Retinal fundus photograph. 2352 by 1568 pixels: 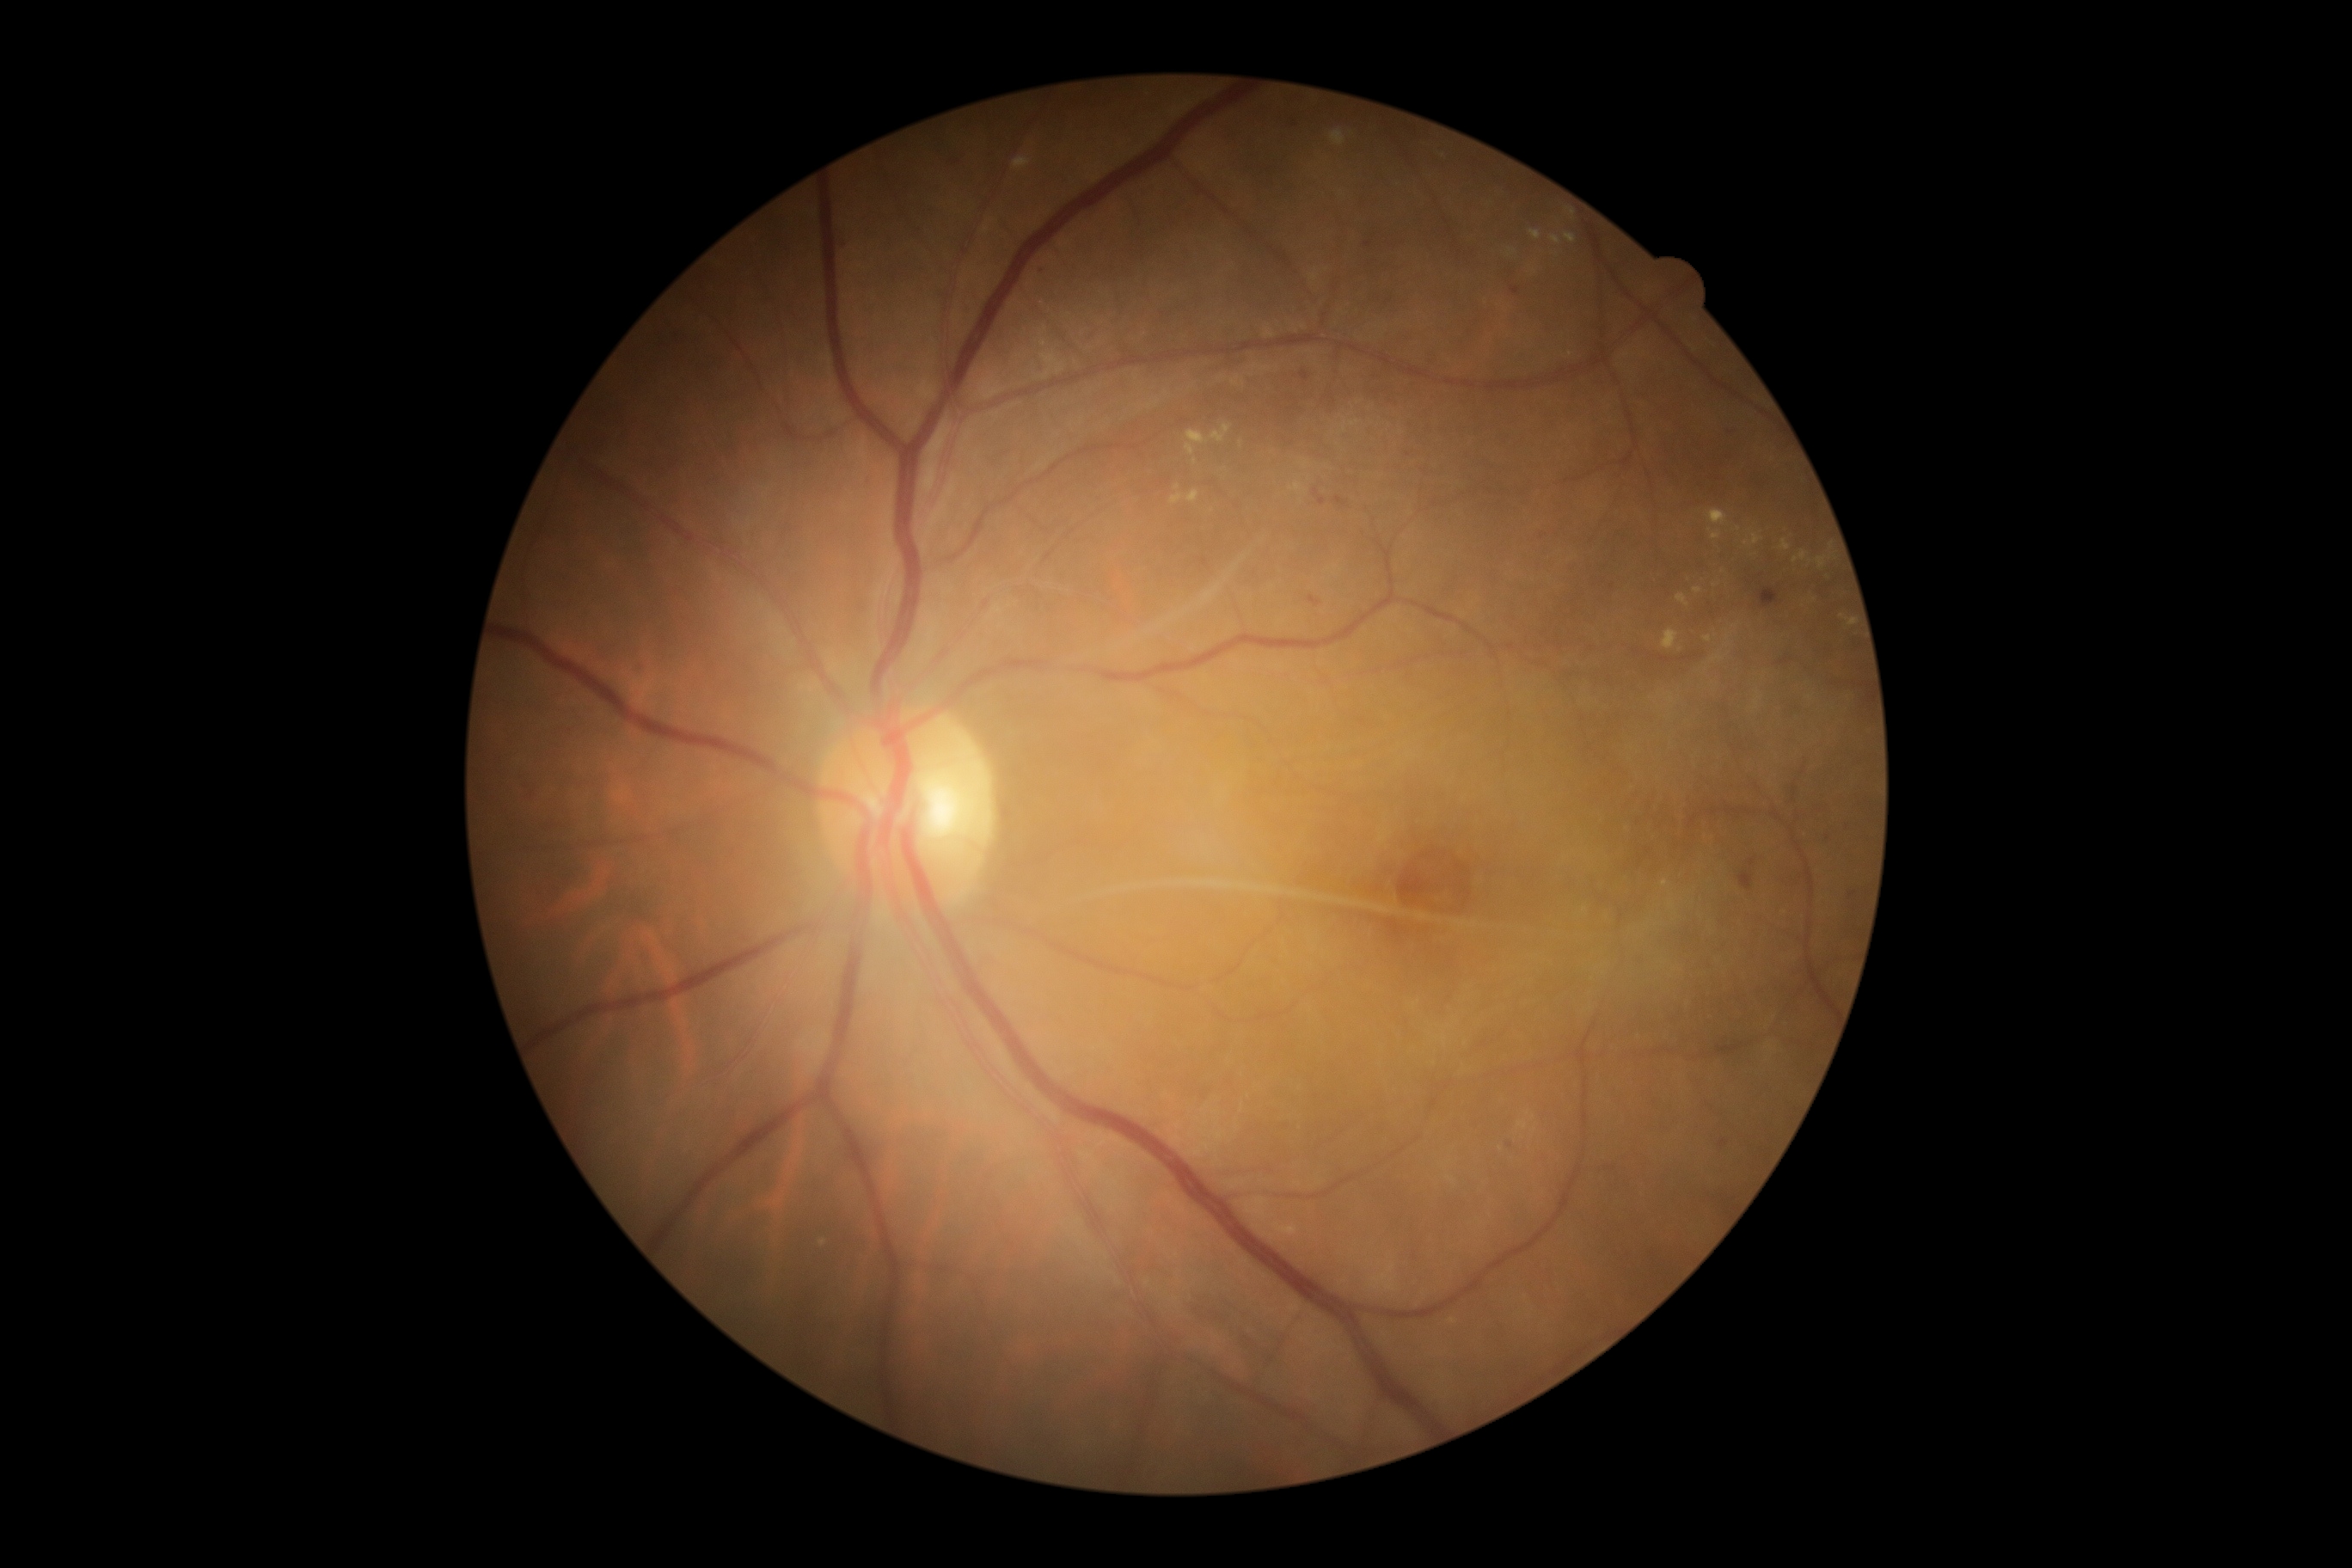

Diabetic retinopathy (DR) is moderate NPDR (grade 2) — more than just microaneurysms but less than severe NPDR; non-proliferative diabetic retinopathy.
Hard exudates (EXs) (partial list) at (left=1170, top=494, right=1184, bottom=505); (left=1662, top=630, right=1679, bottom=651); (left=1012, top=157, right=1032, bottom=171); (left=1332, top=130, right=1345, bottom=147); (left=1565, top=209, right=1576, bottom=217); (left=1841, top=615, right=1856, bottom=627); (left=1211, top=424, right=1232, bottom=444); (left=1529, top=231, right=1543, bottom=240); (left=1779, top=539, right=1792, bottom=551); (left=1816, top=556, right=1828, bottom=570); (left=1517, top=1122, right=1529, bottom=1130).
Additional small EXs near pt(1453, 1322); pt(1708, 639); pt(1242, 445); pt(1756, 709); pt(1736, 626); pt(1727, 645); pt(1728, 638); pt(1533, 1131); pt(1194, 462).